NIDEK AFC-230 fundus camera. FOV: 45 degrees — 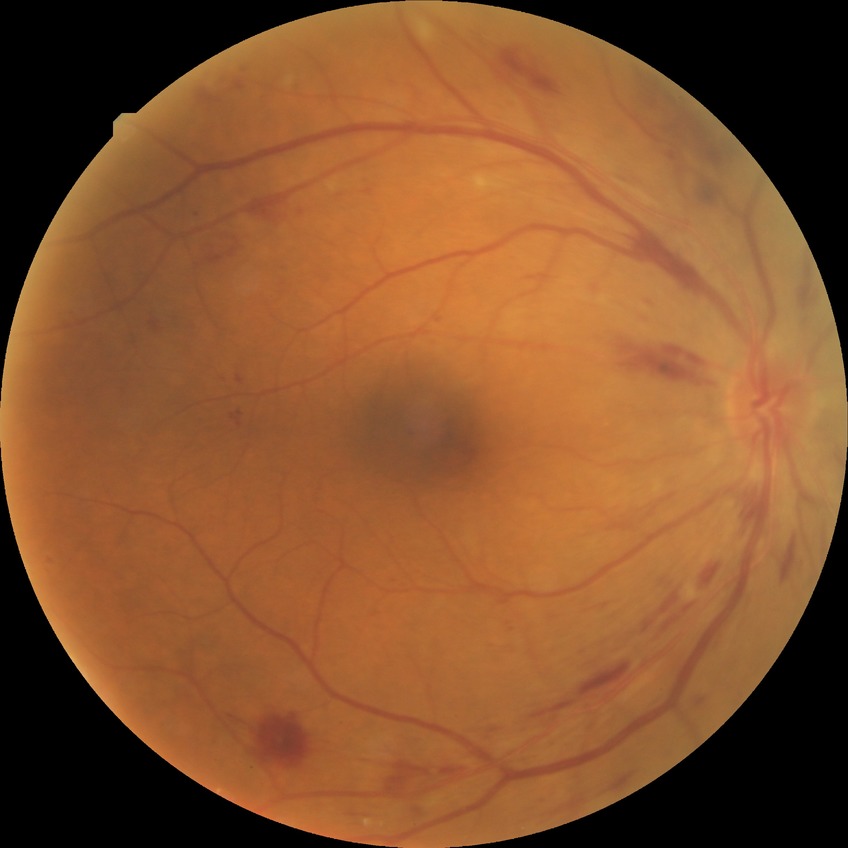
Diabetic retinopathy (DR) is pre-proliferative diabetic retinopathy (PPDR).